Pediatric wide-field fundus photograph: 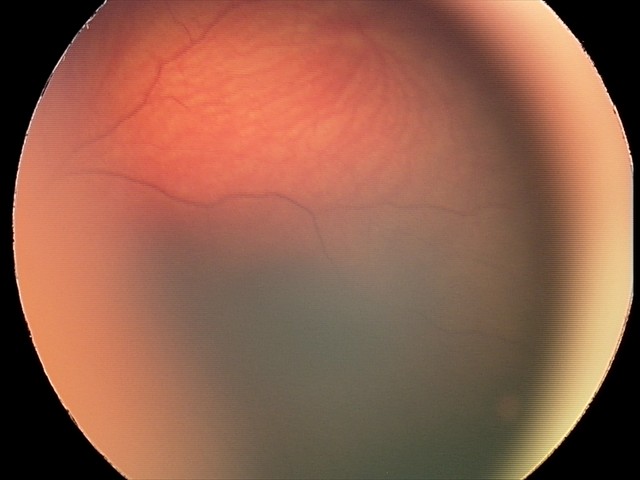
Diagnosis from this screening exam: retinal hemorrhages.